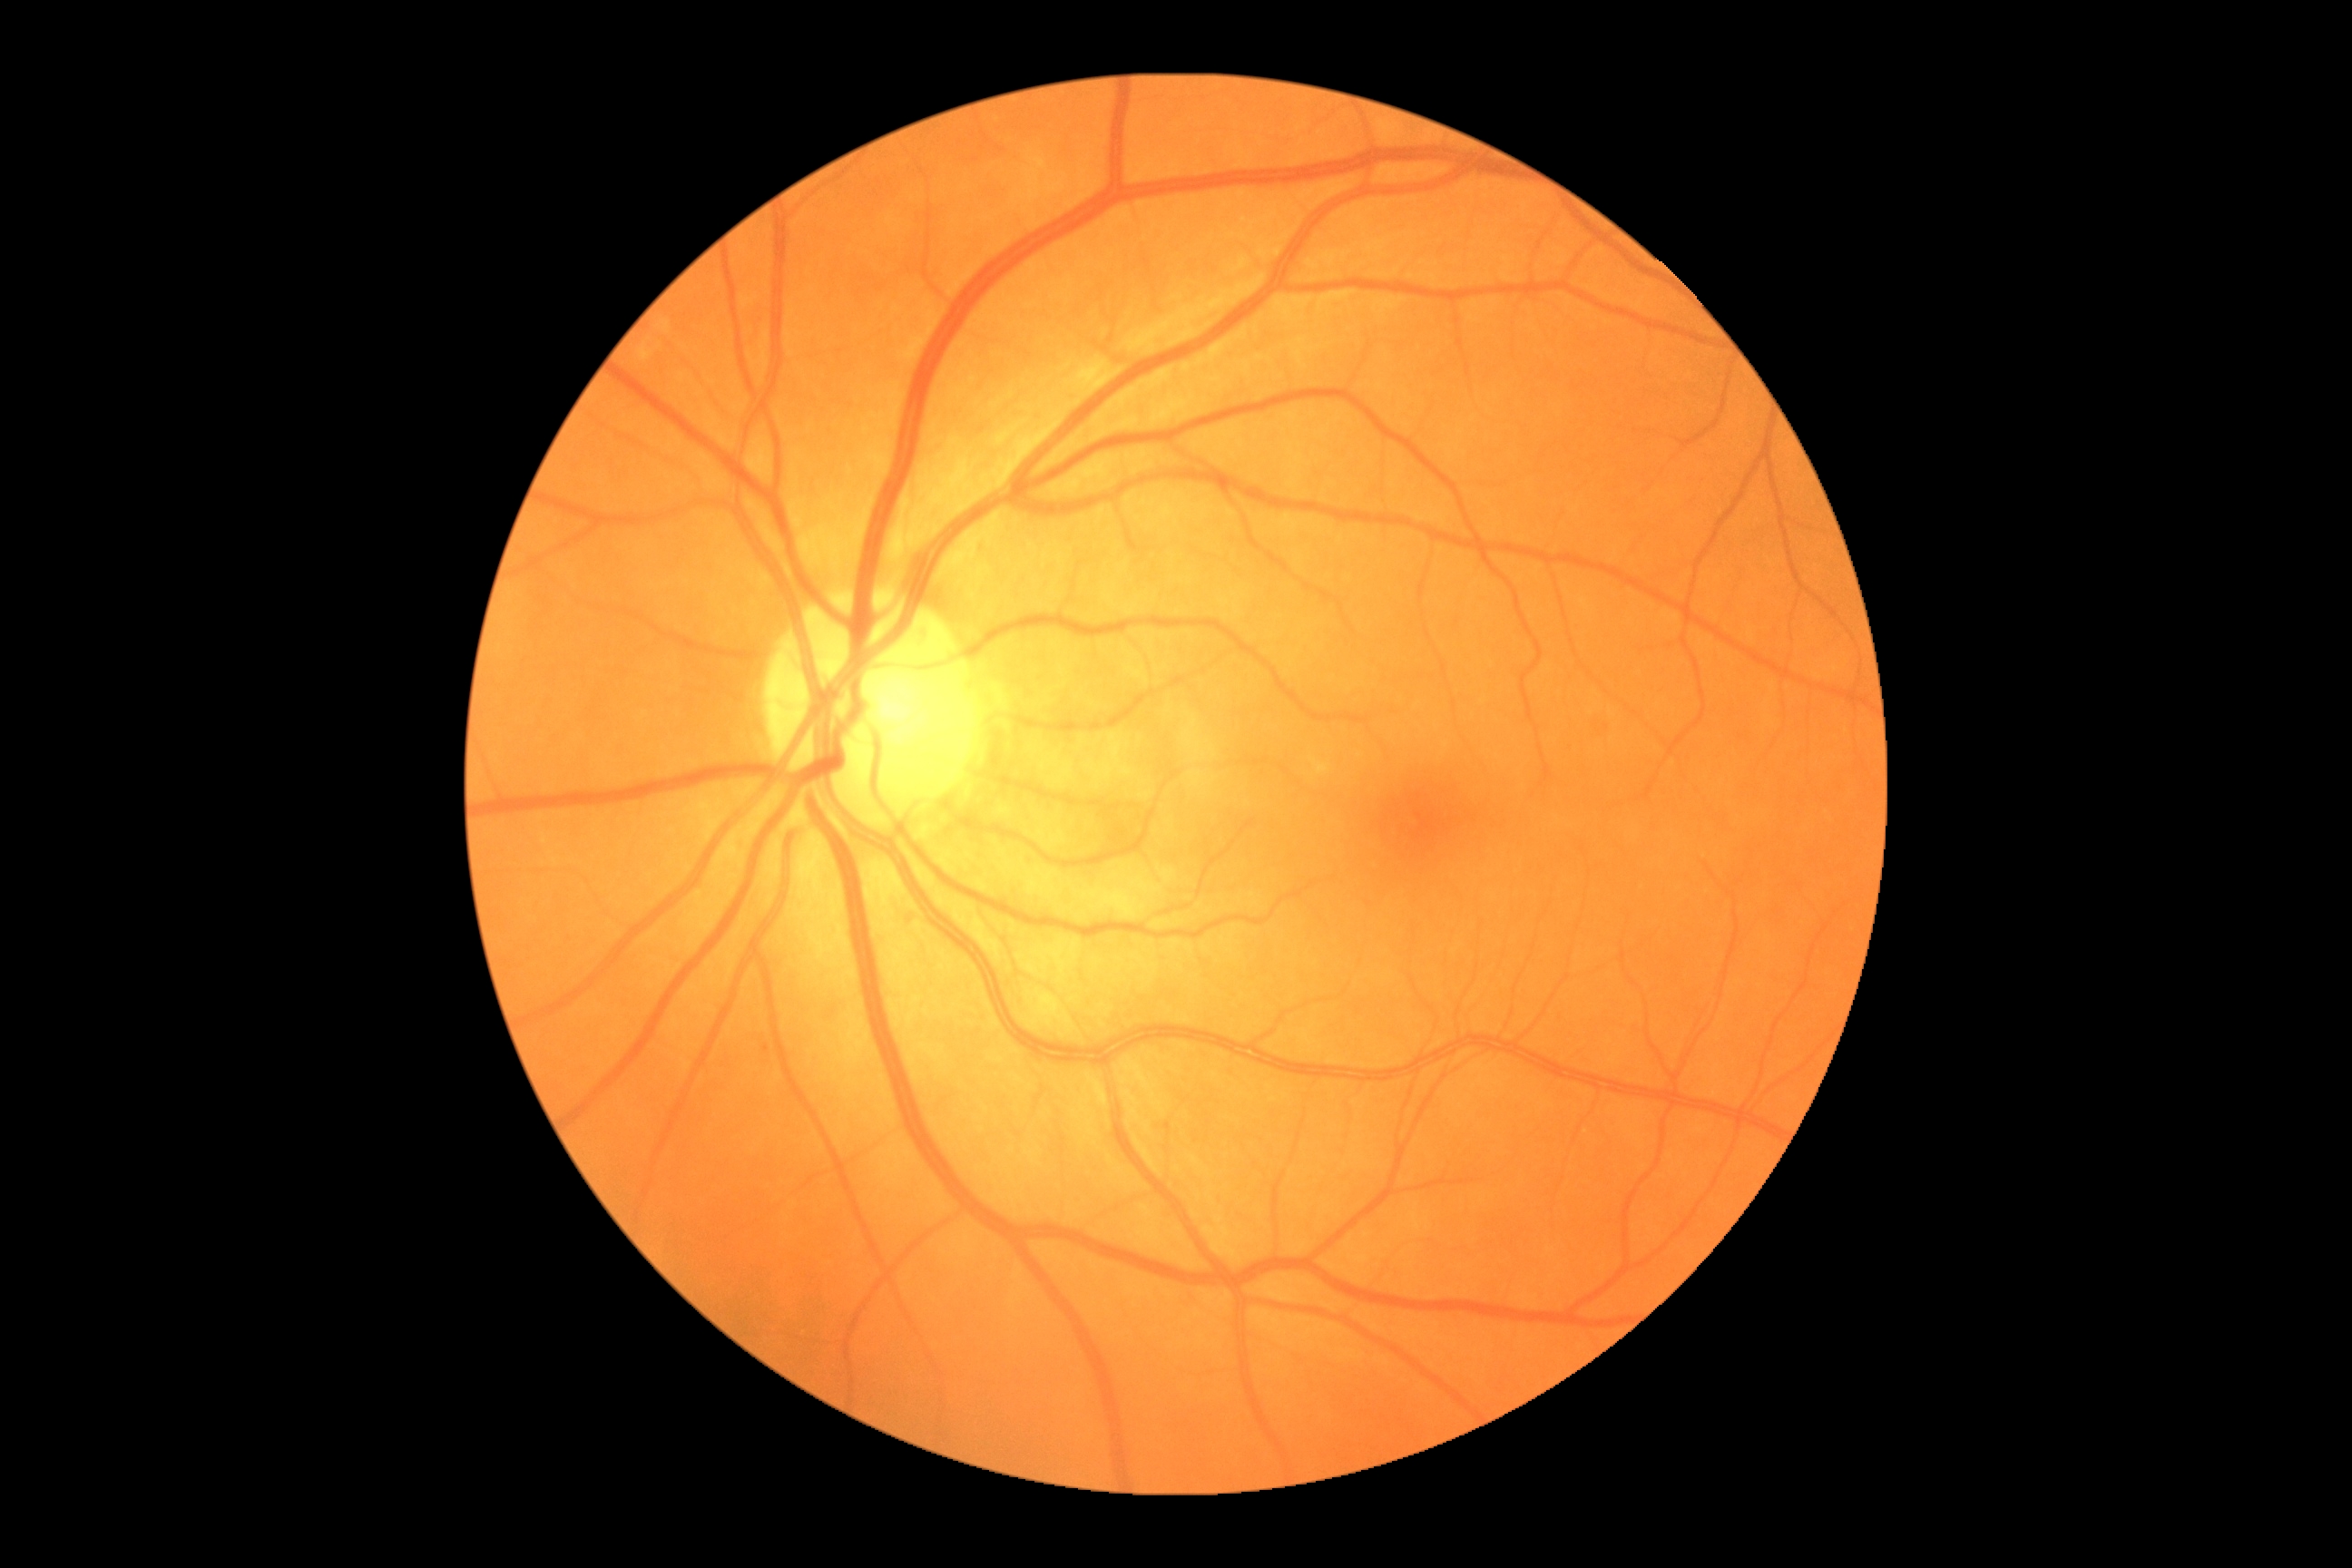

Diabetic retinopathy severity: 0/4.